Wide-field fundus photograph of an infant; 1240x1240: 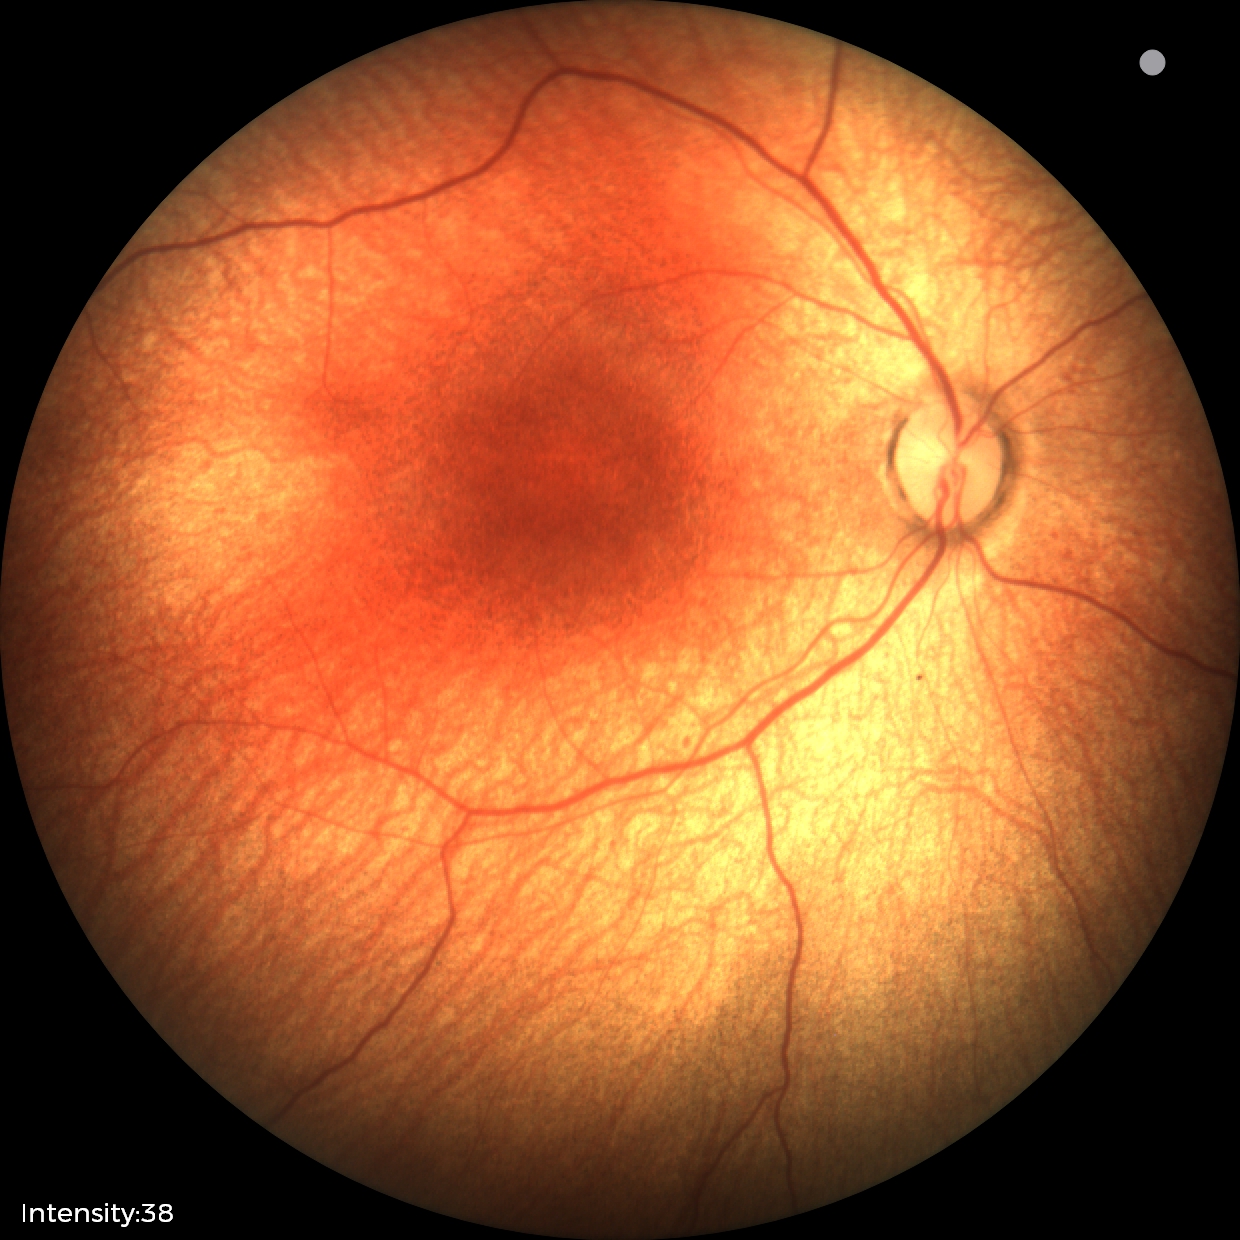 Assessment: no abnormal retinal findings.